Wide-field fundus photograph from neonatal ROP screening — 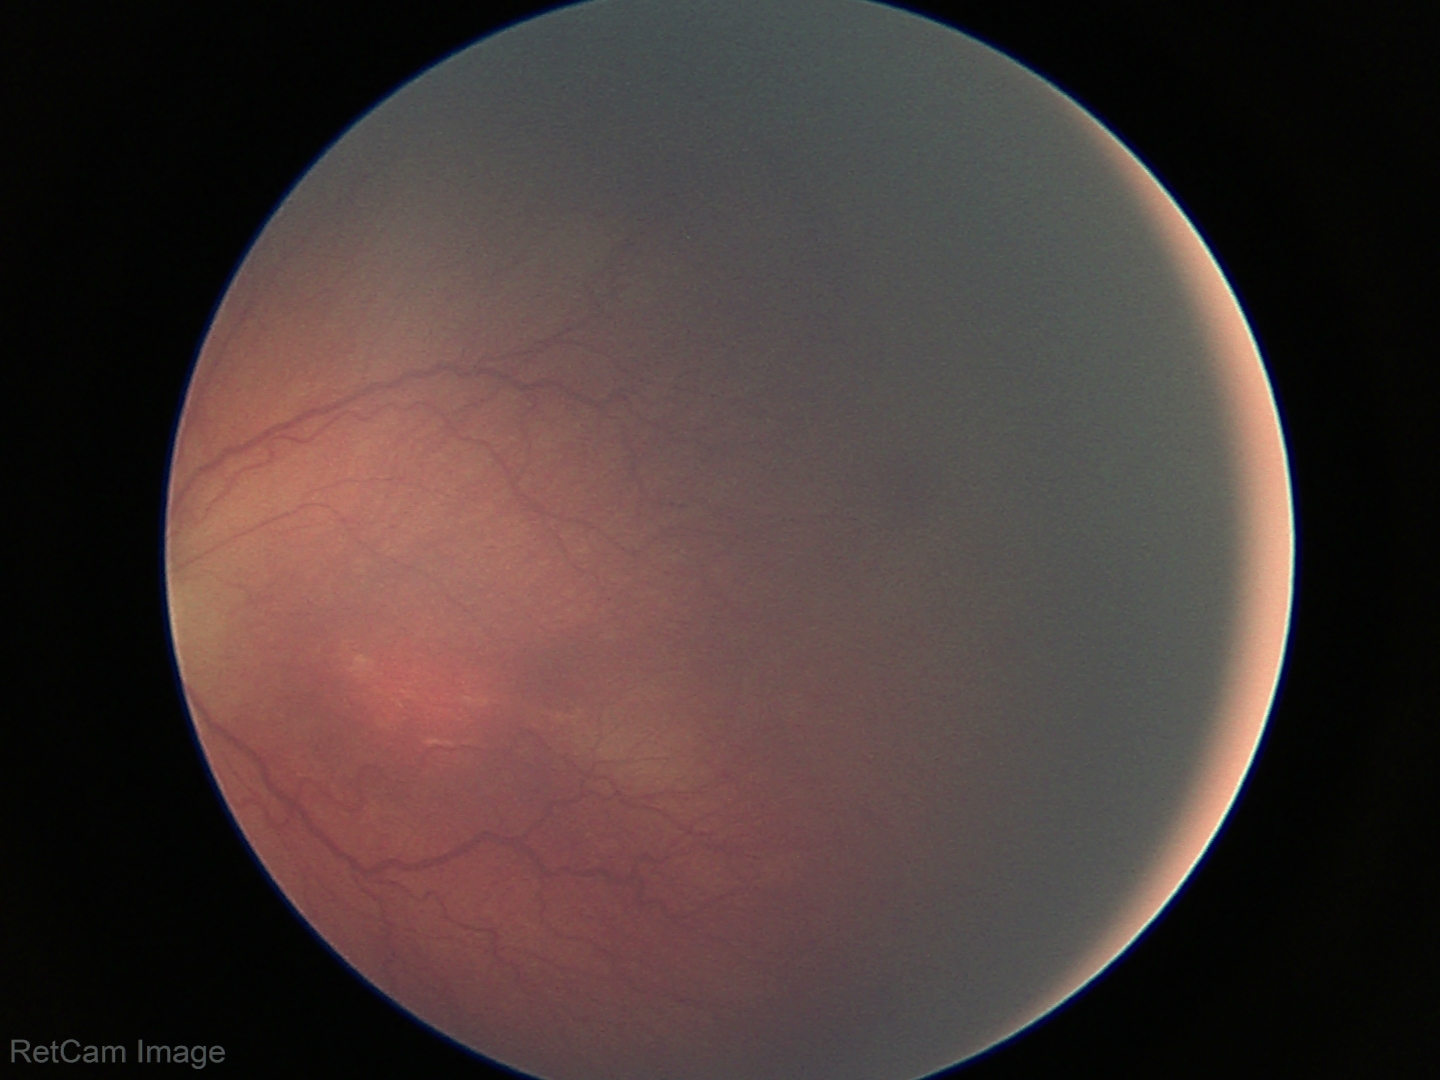
Plus form: absent
impression: ROP stage 2 — ridge with height and width at the demarcation line